CFP: 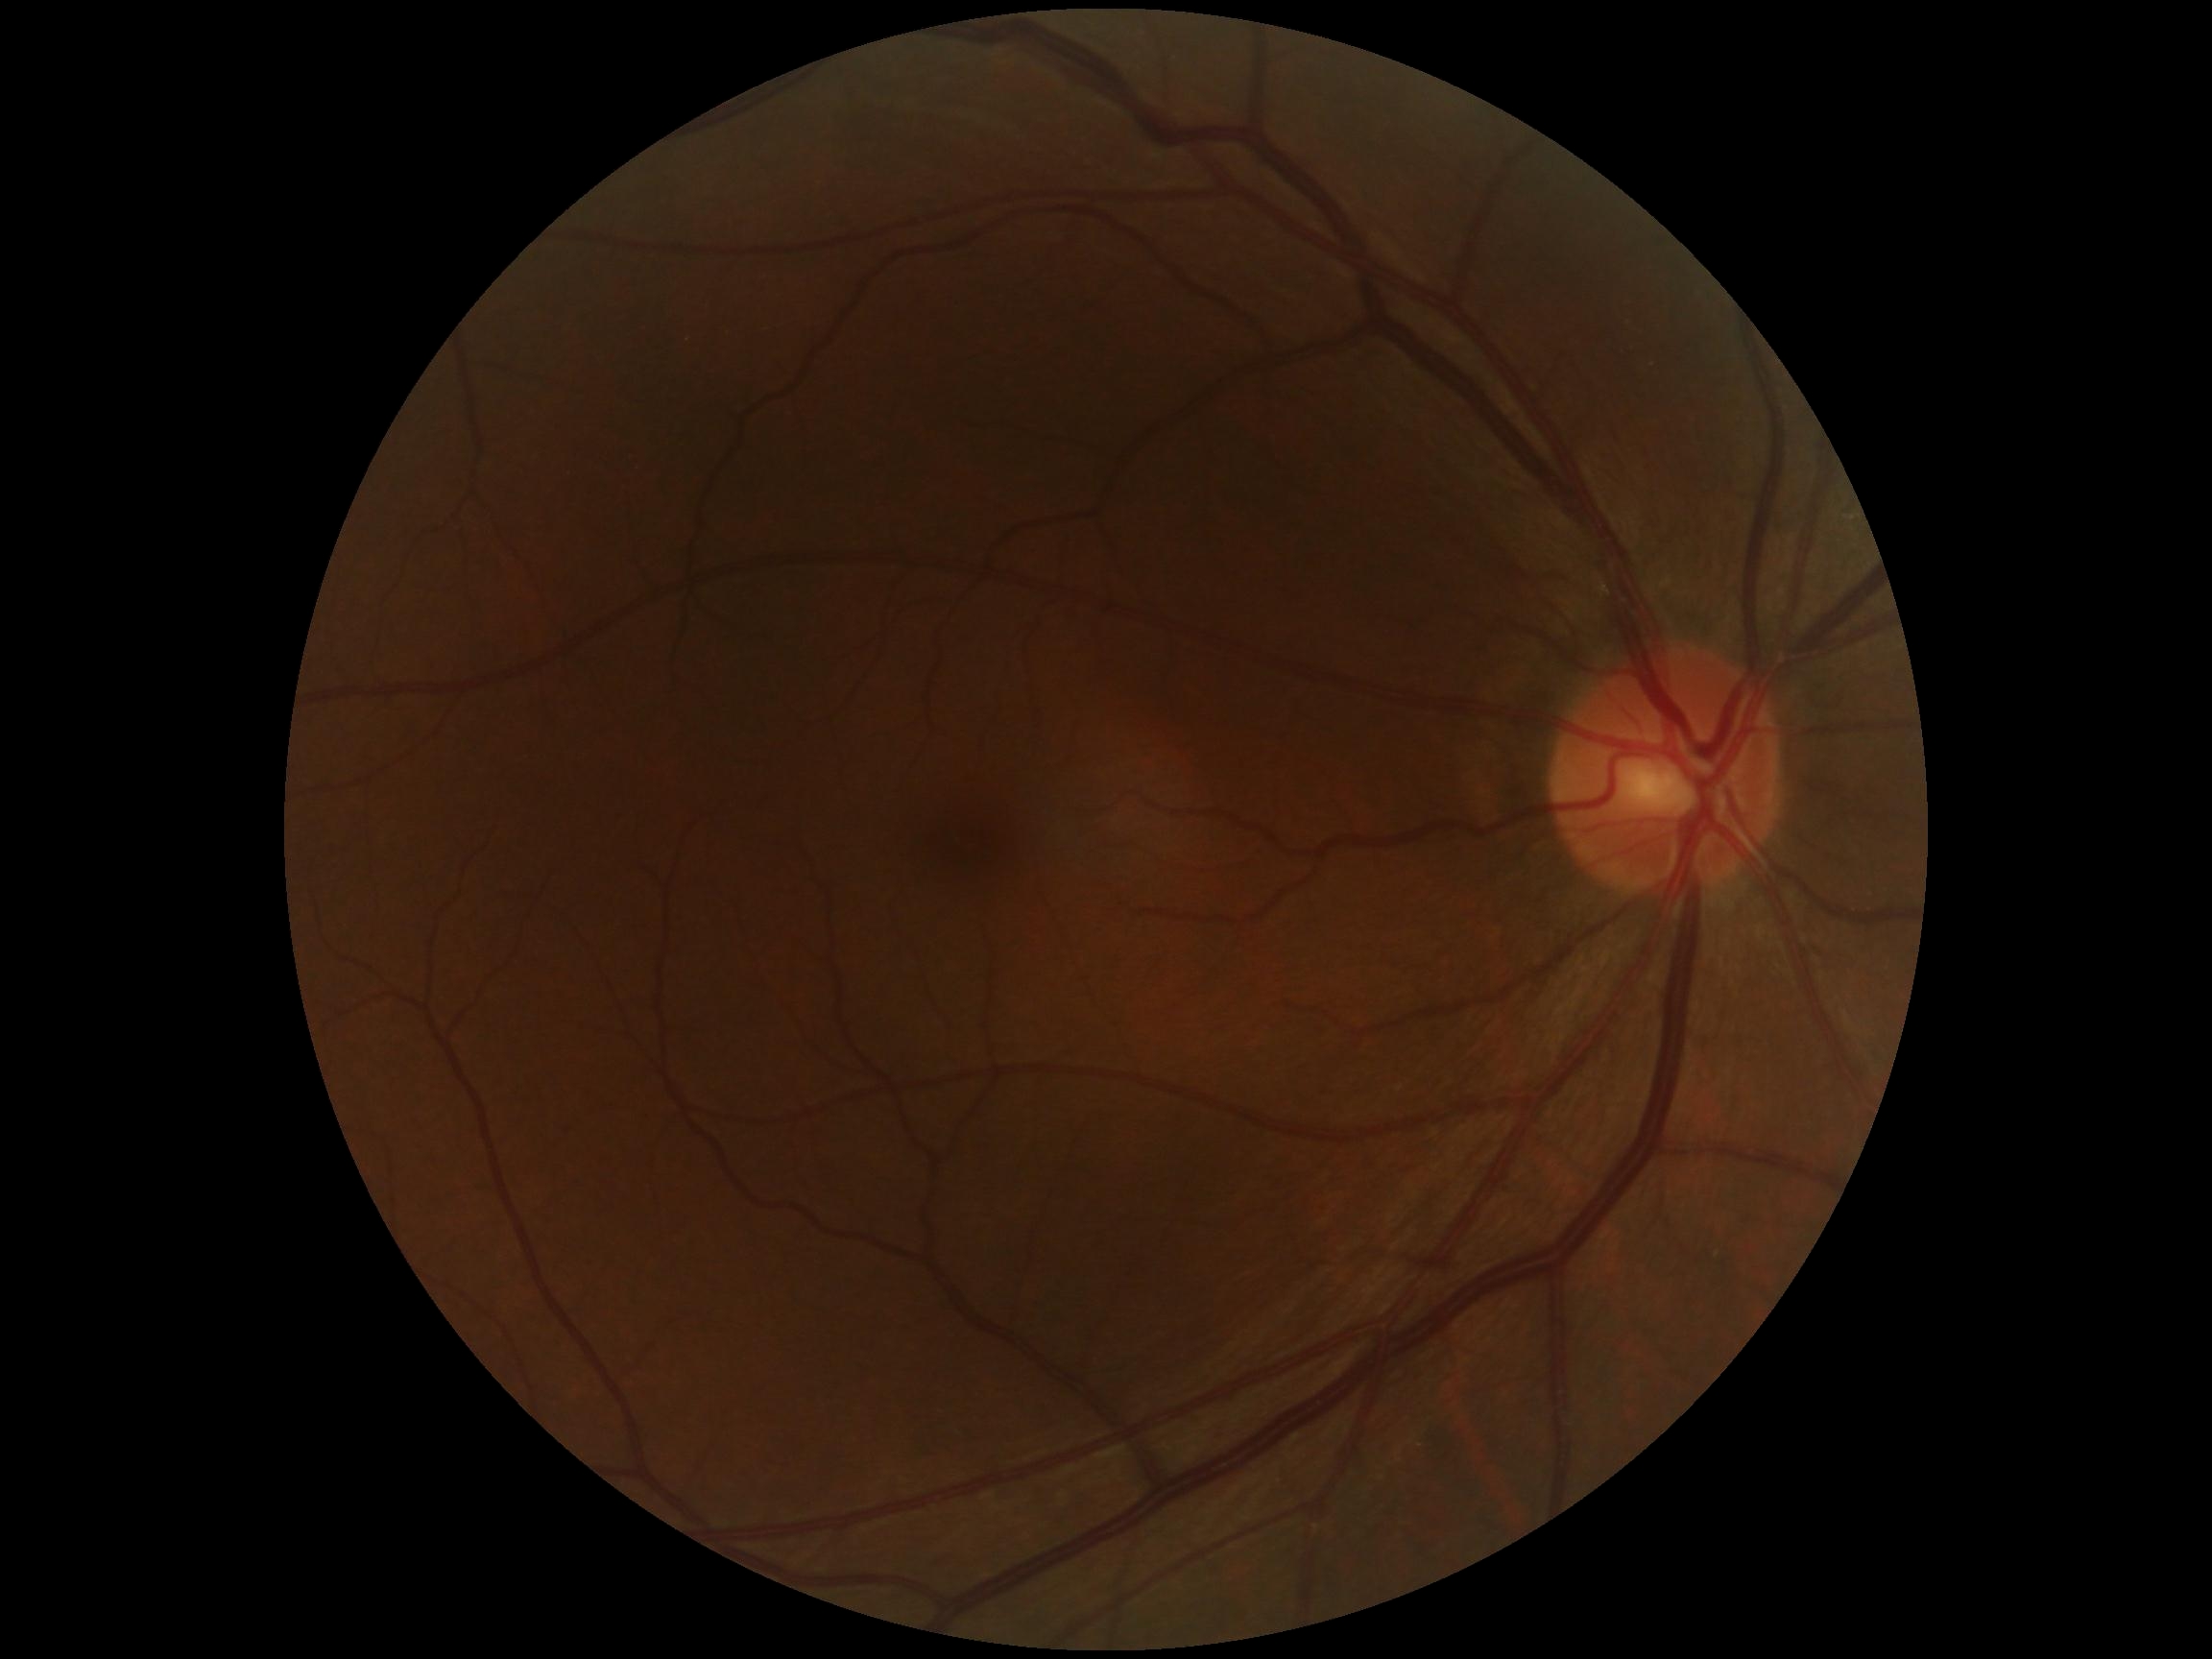
diabetic retinopathy severity: grade 0, DR impression: no apparent DR.